2352x1568px; color fundus photograph; 45° FOV.
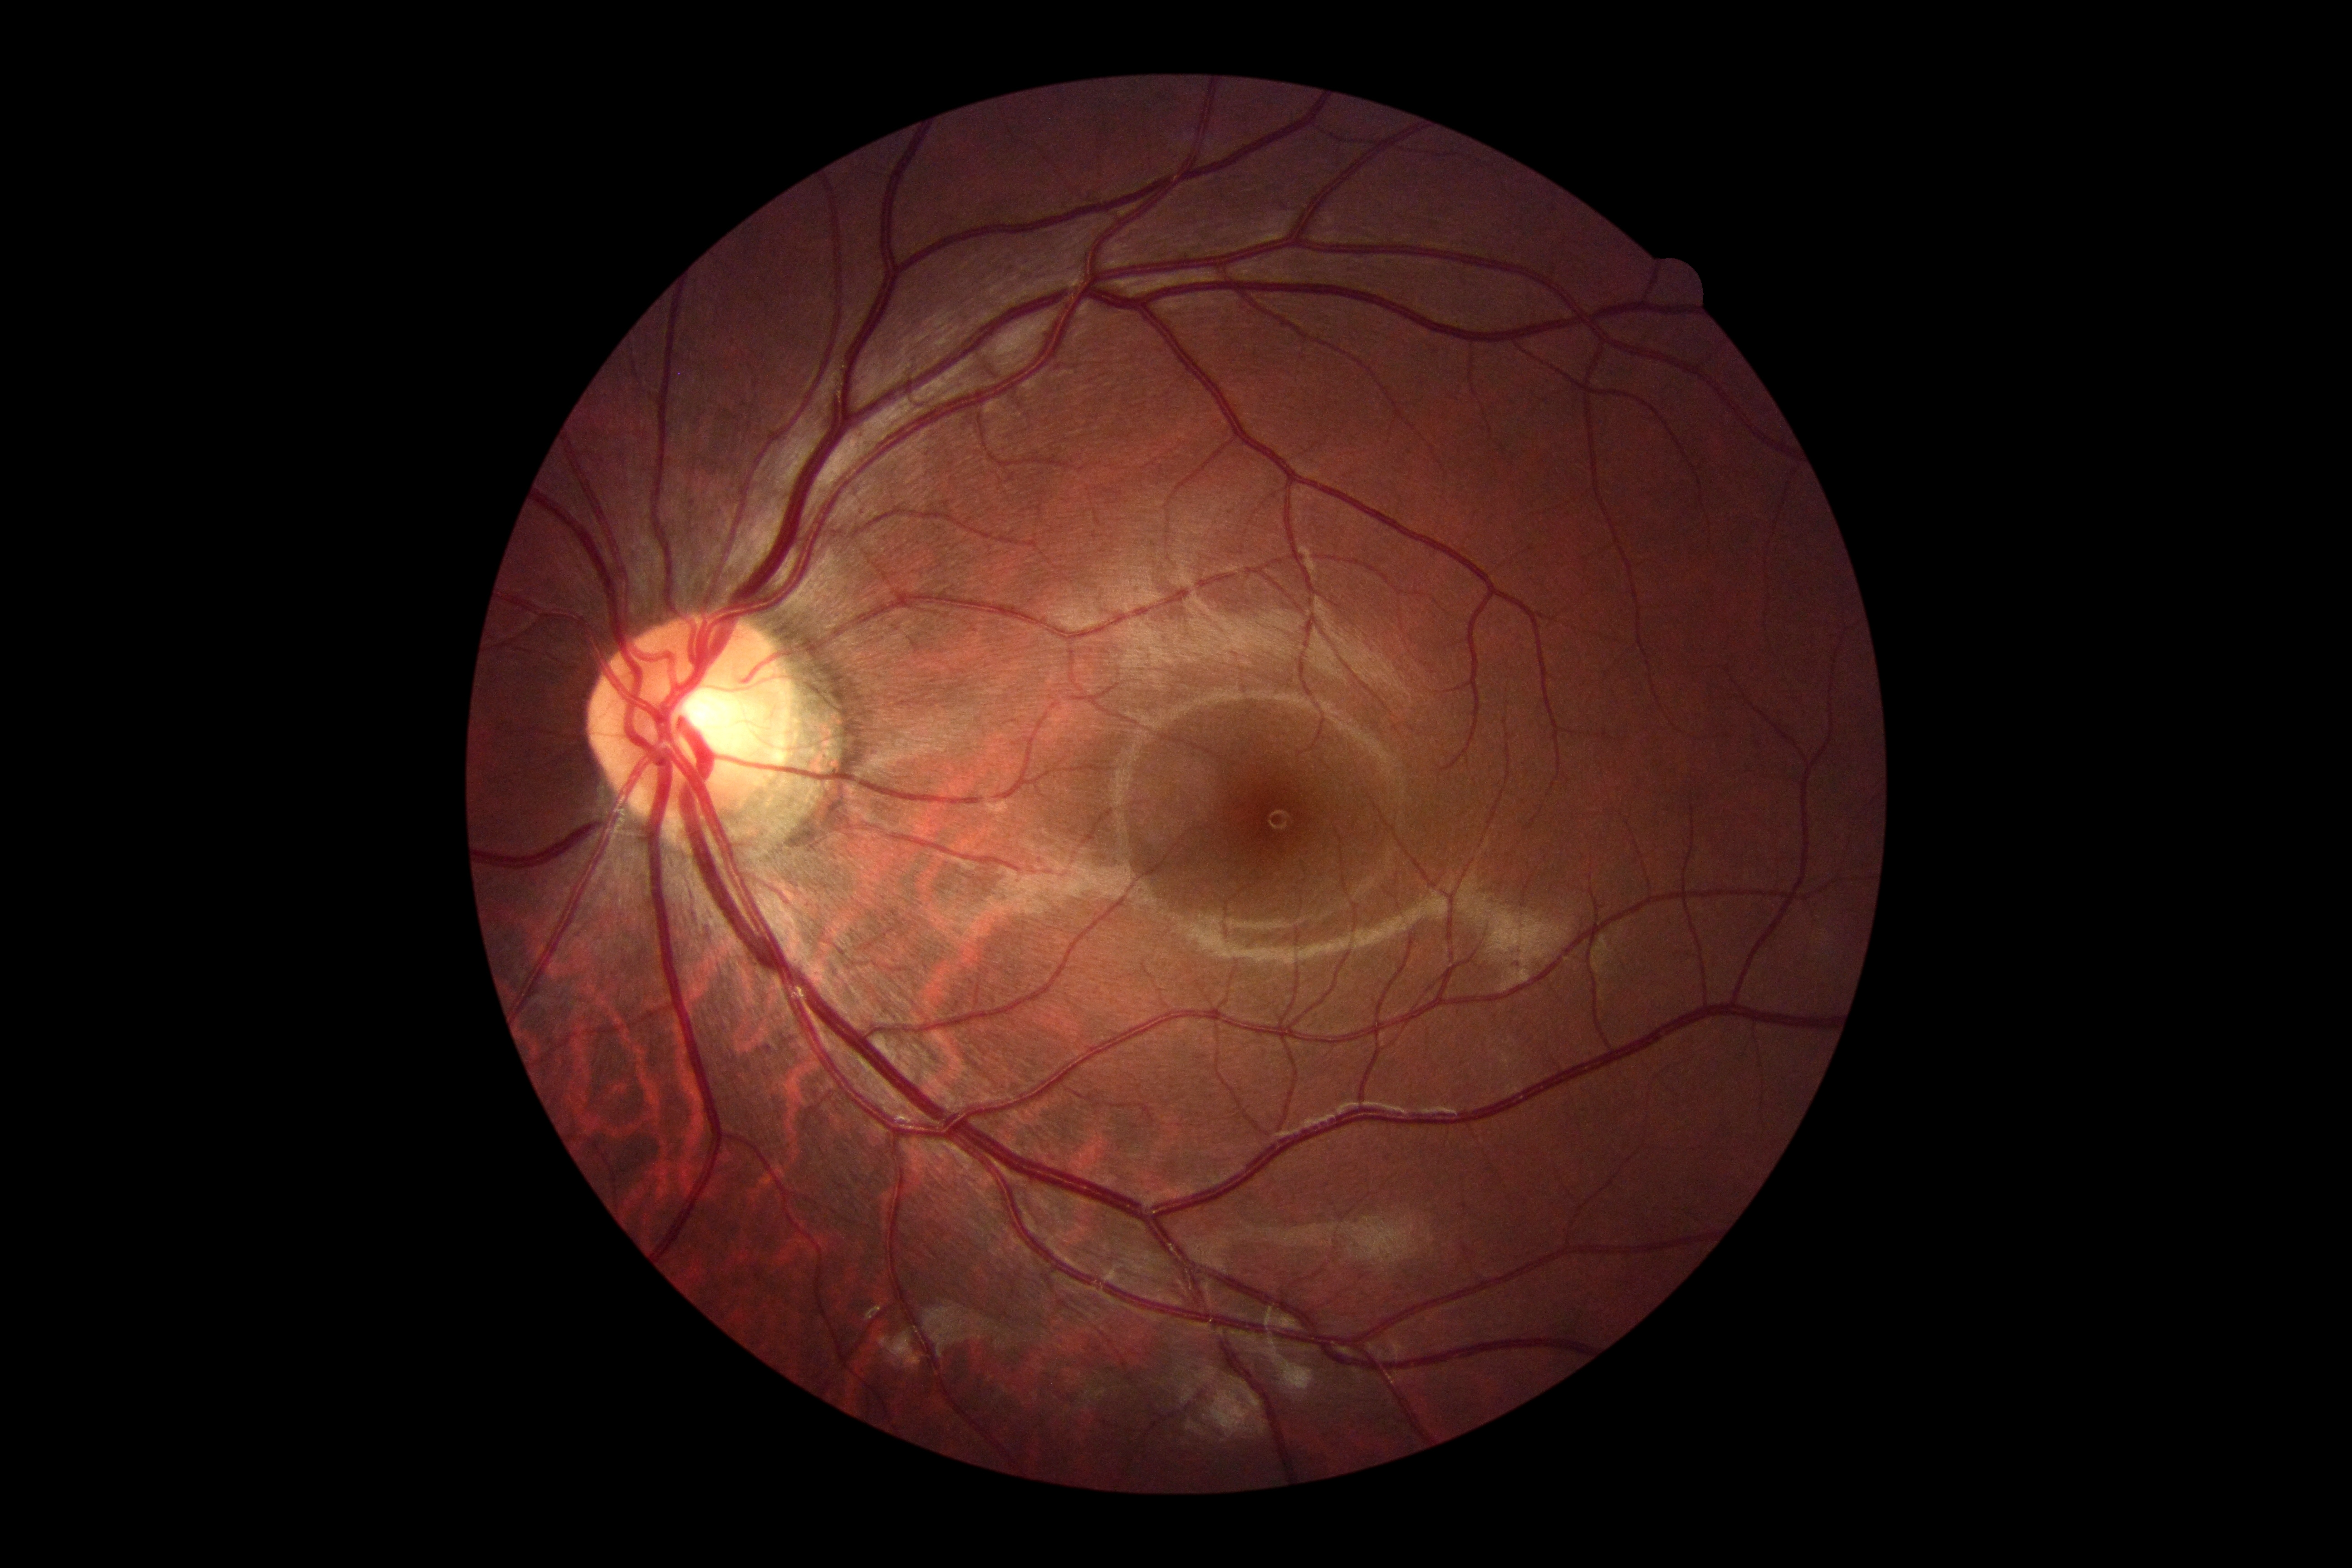 DR grade: 0.